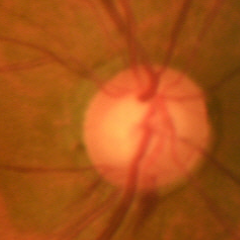
Findings consistent with glaucoma. Glaucoma diagnosis = early glaucomatous changes.